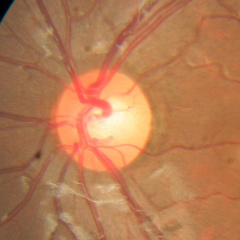 No glaucomatous findings.